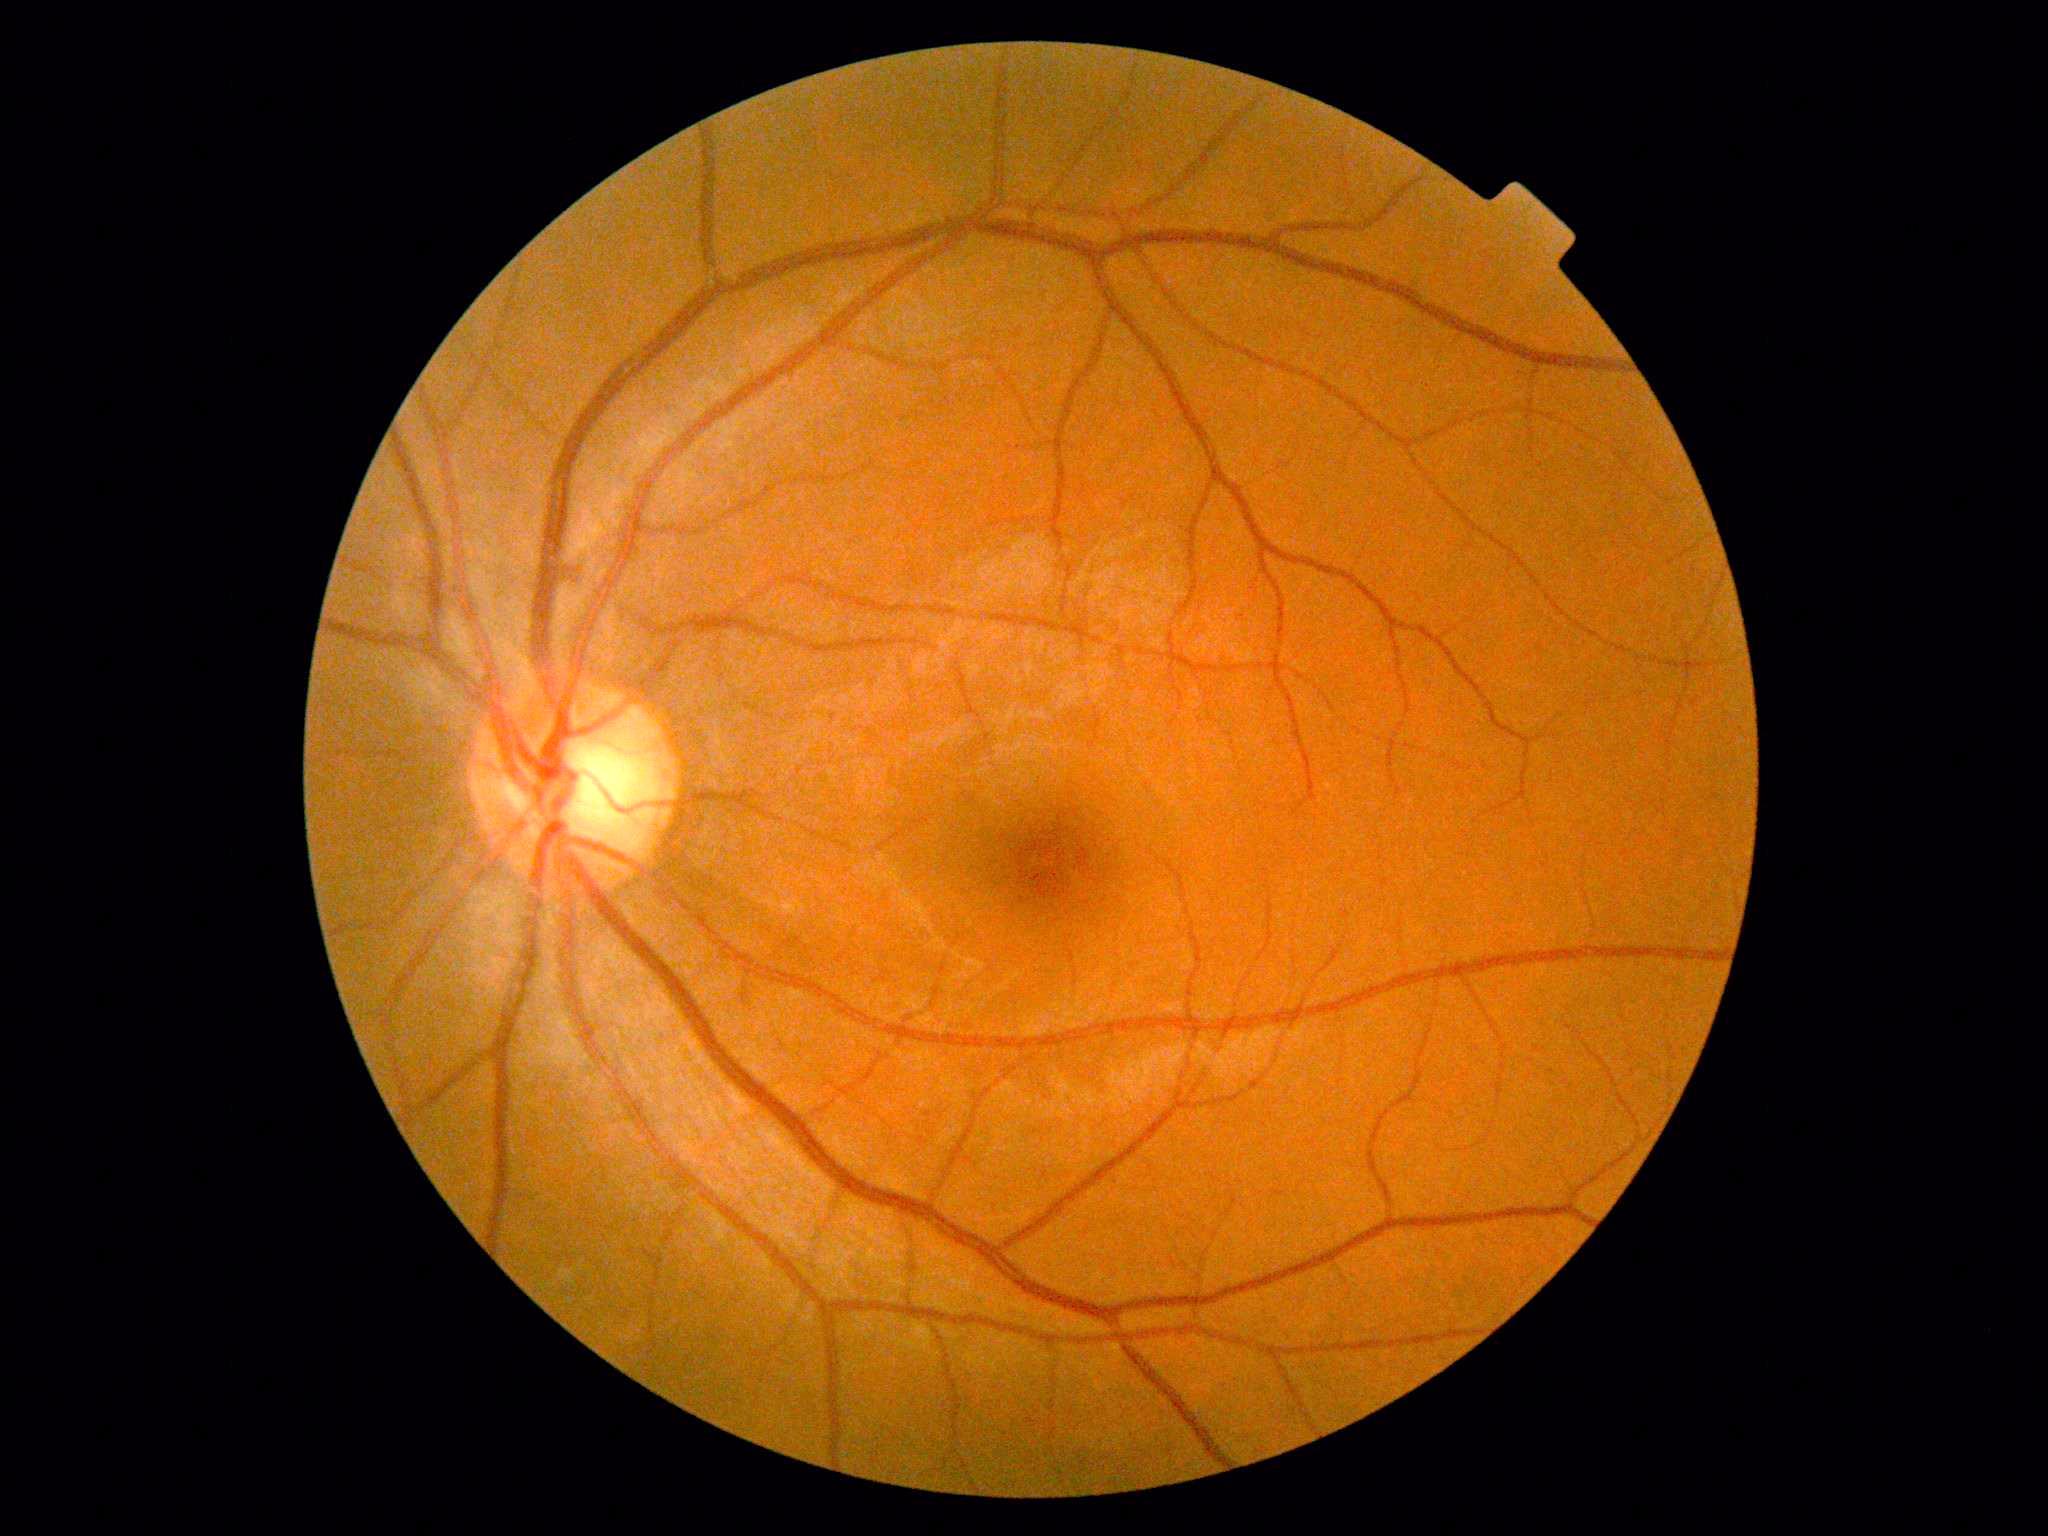

Retinopathy is 0/4.